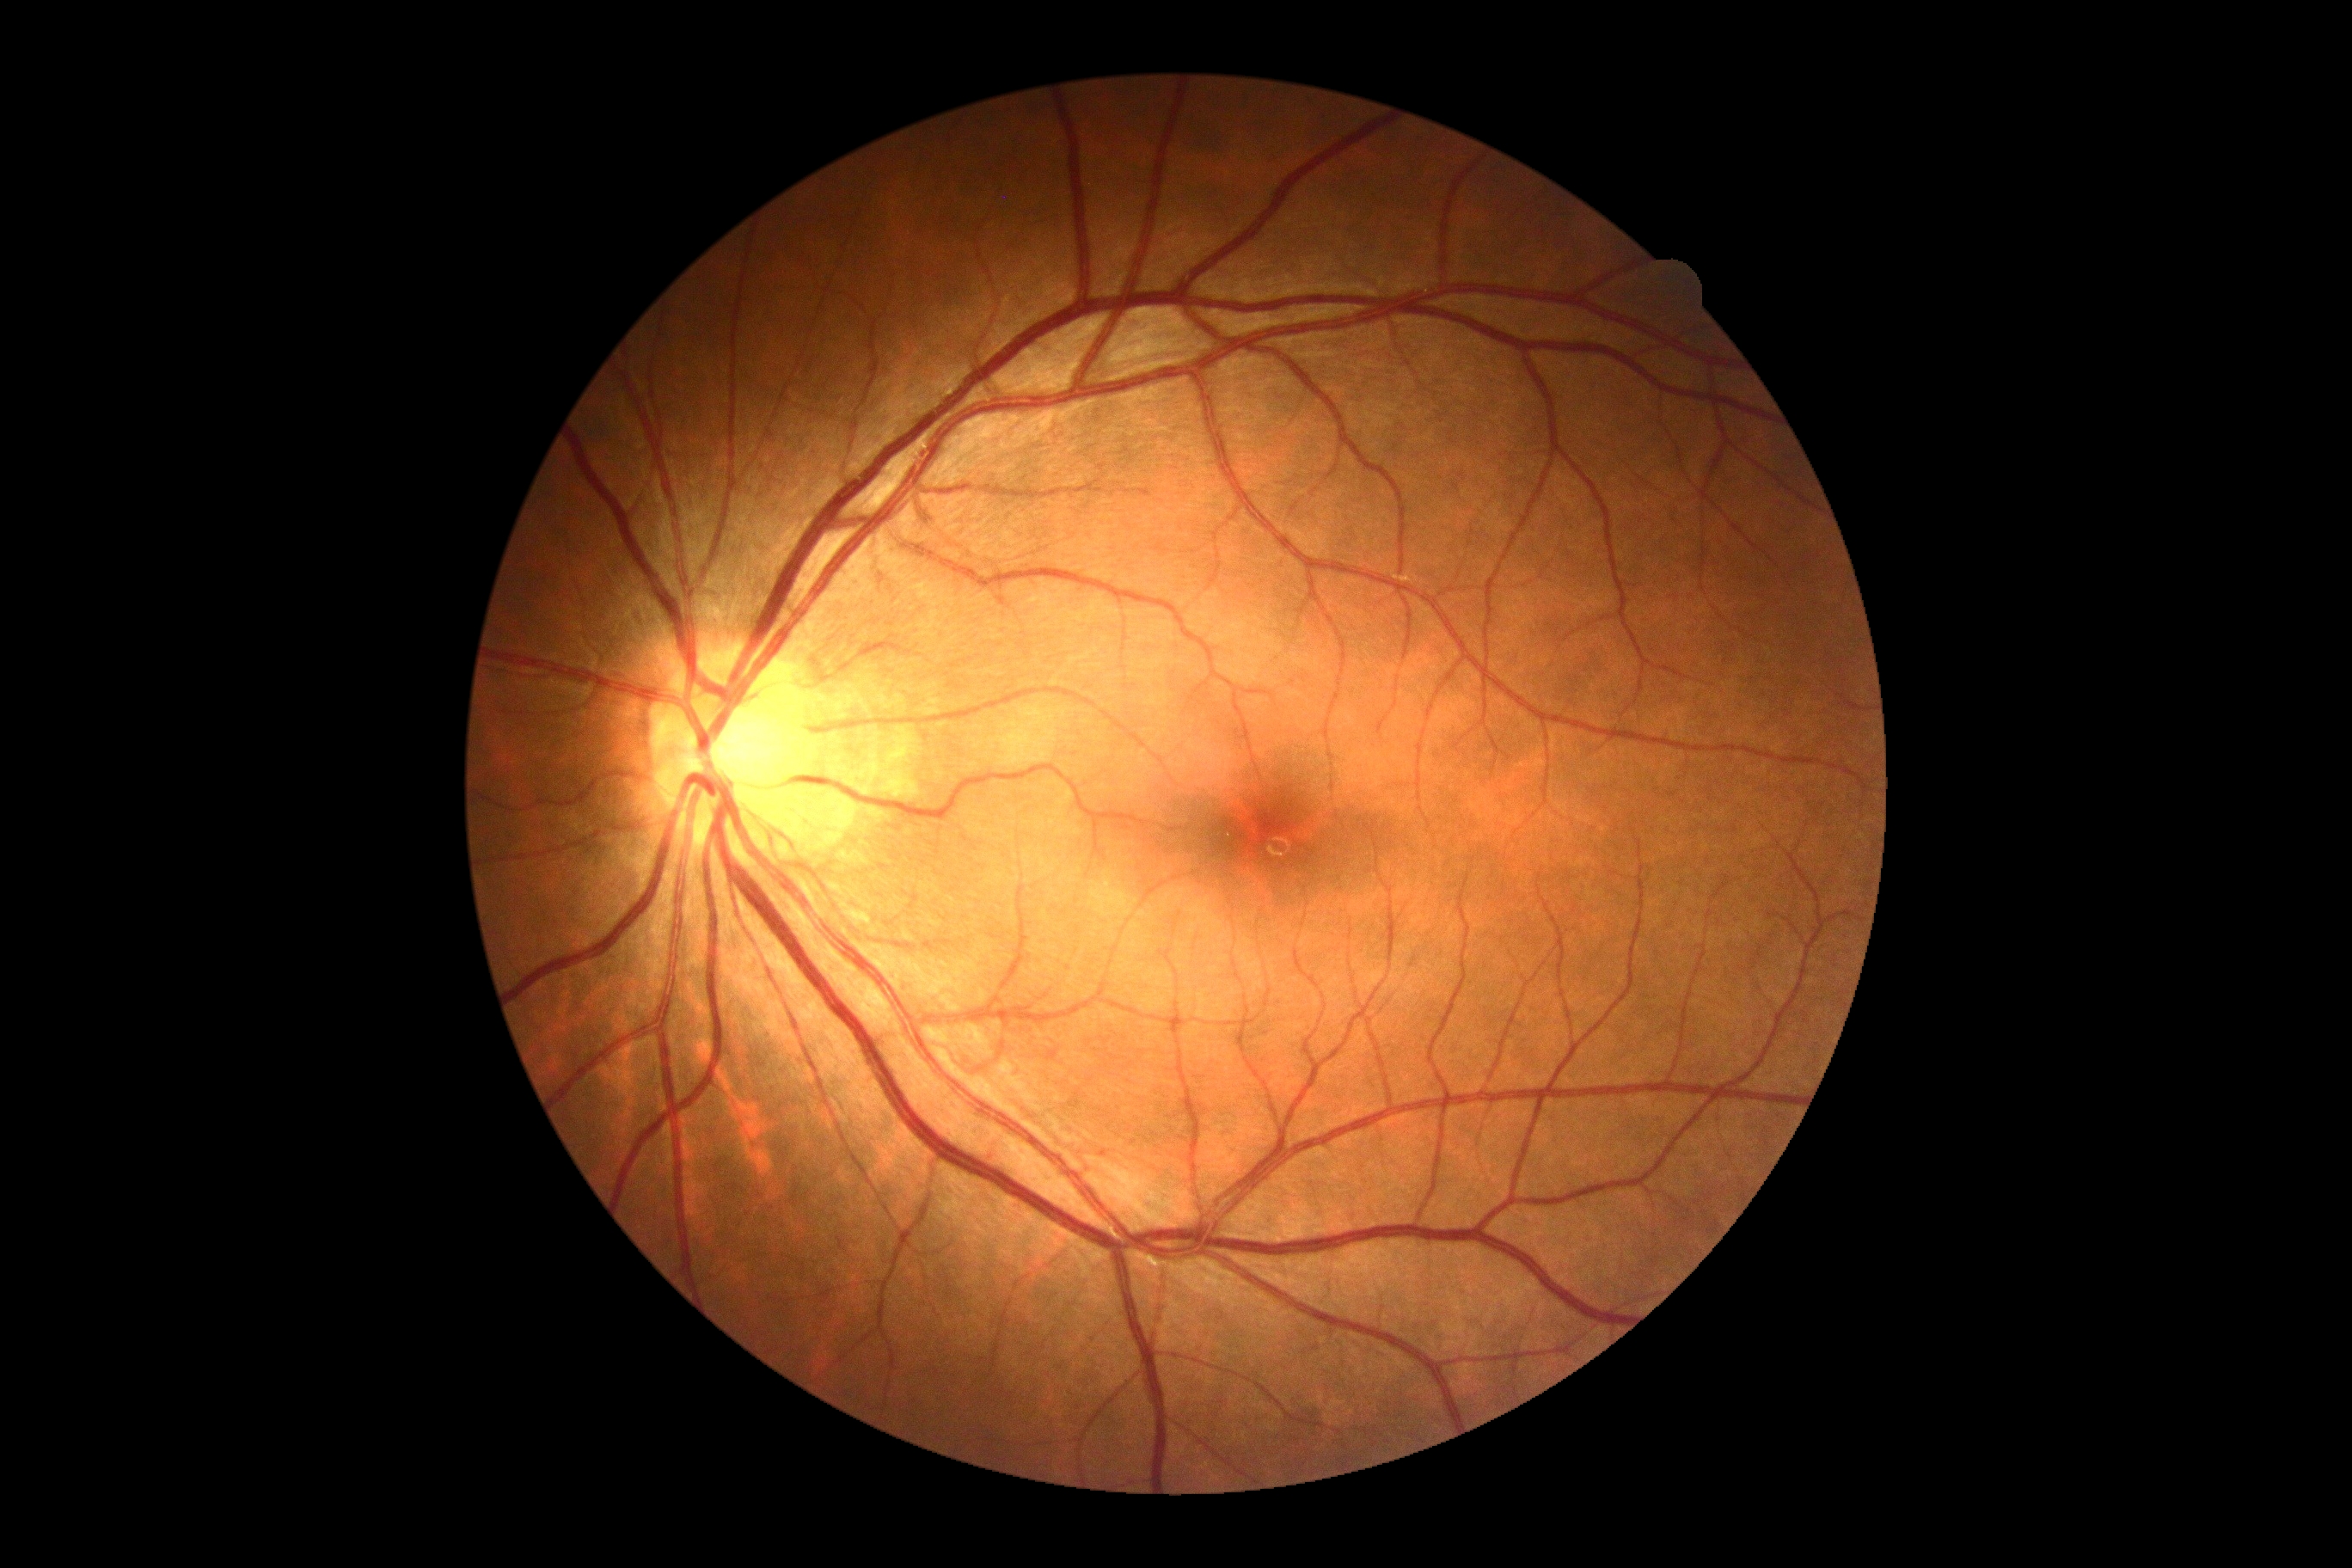
DR impression = no signs of DR | DR = no apparent diabetic retinopathy (grade 0).